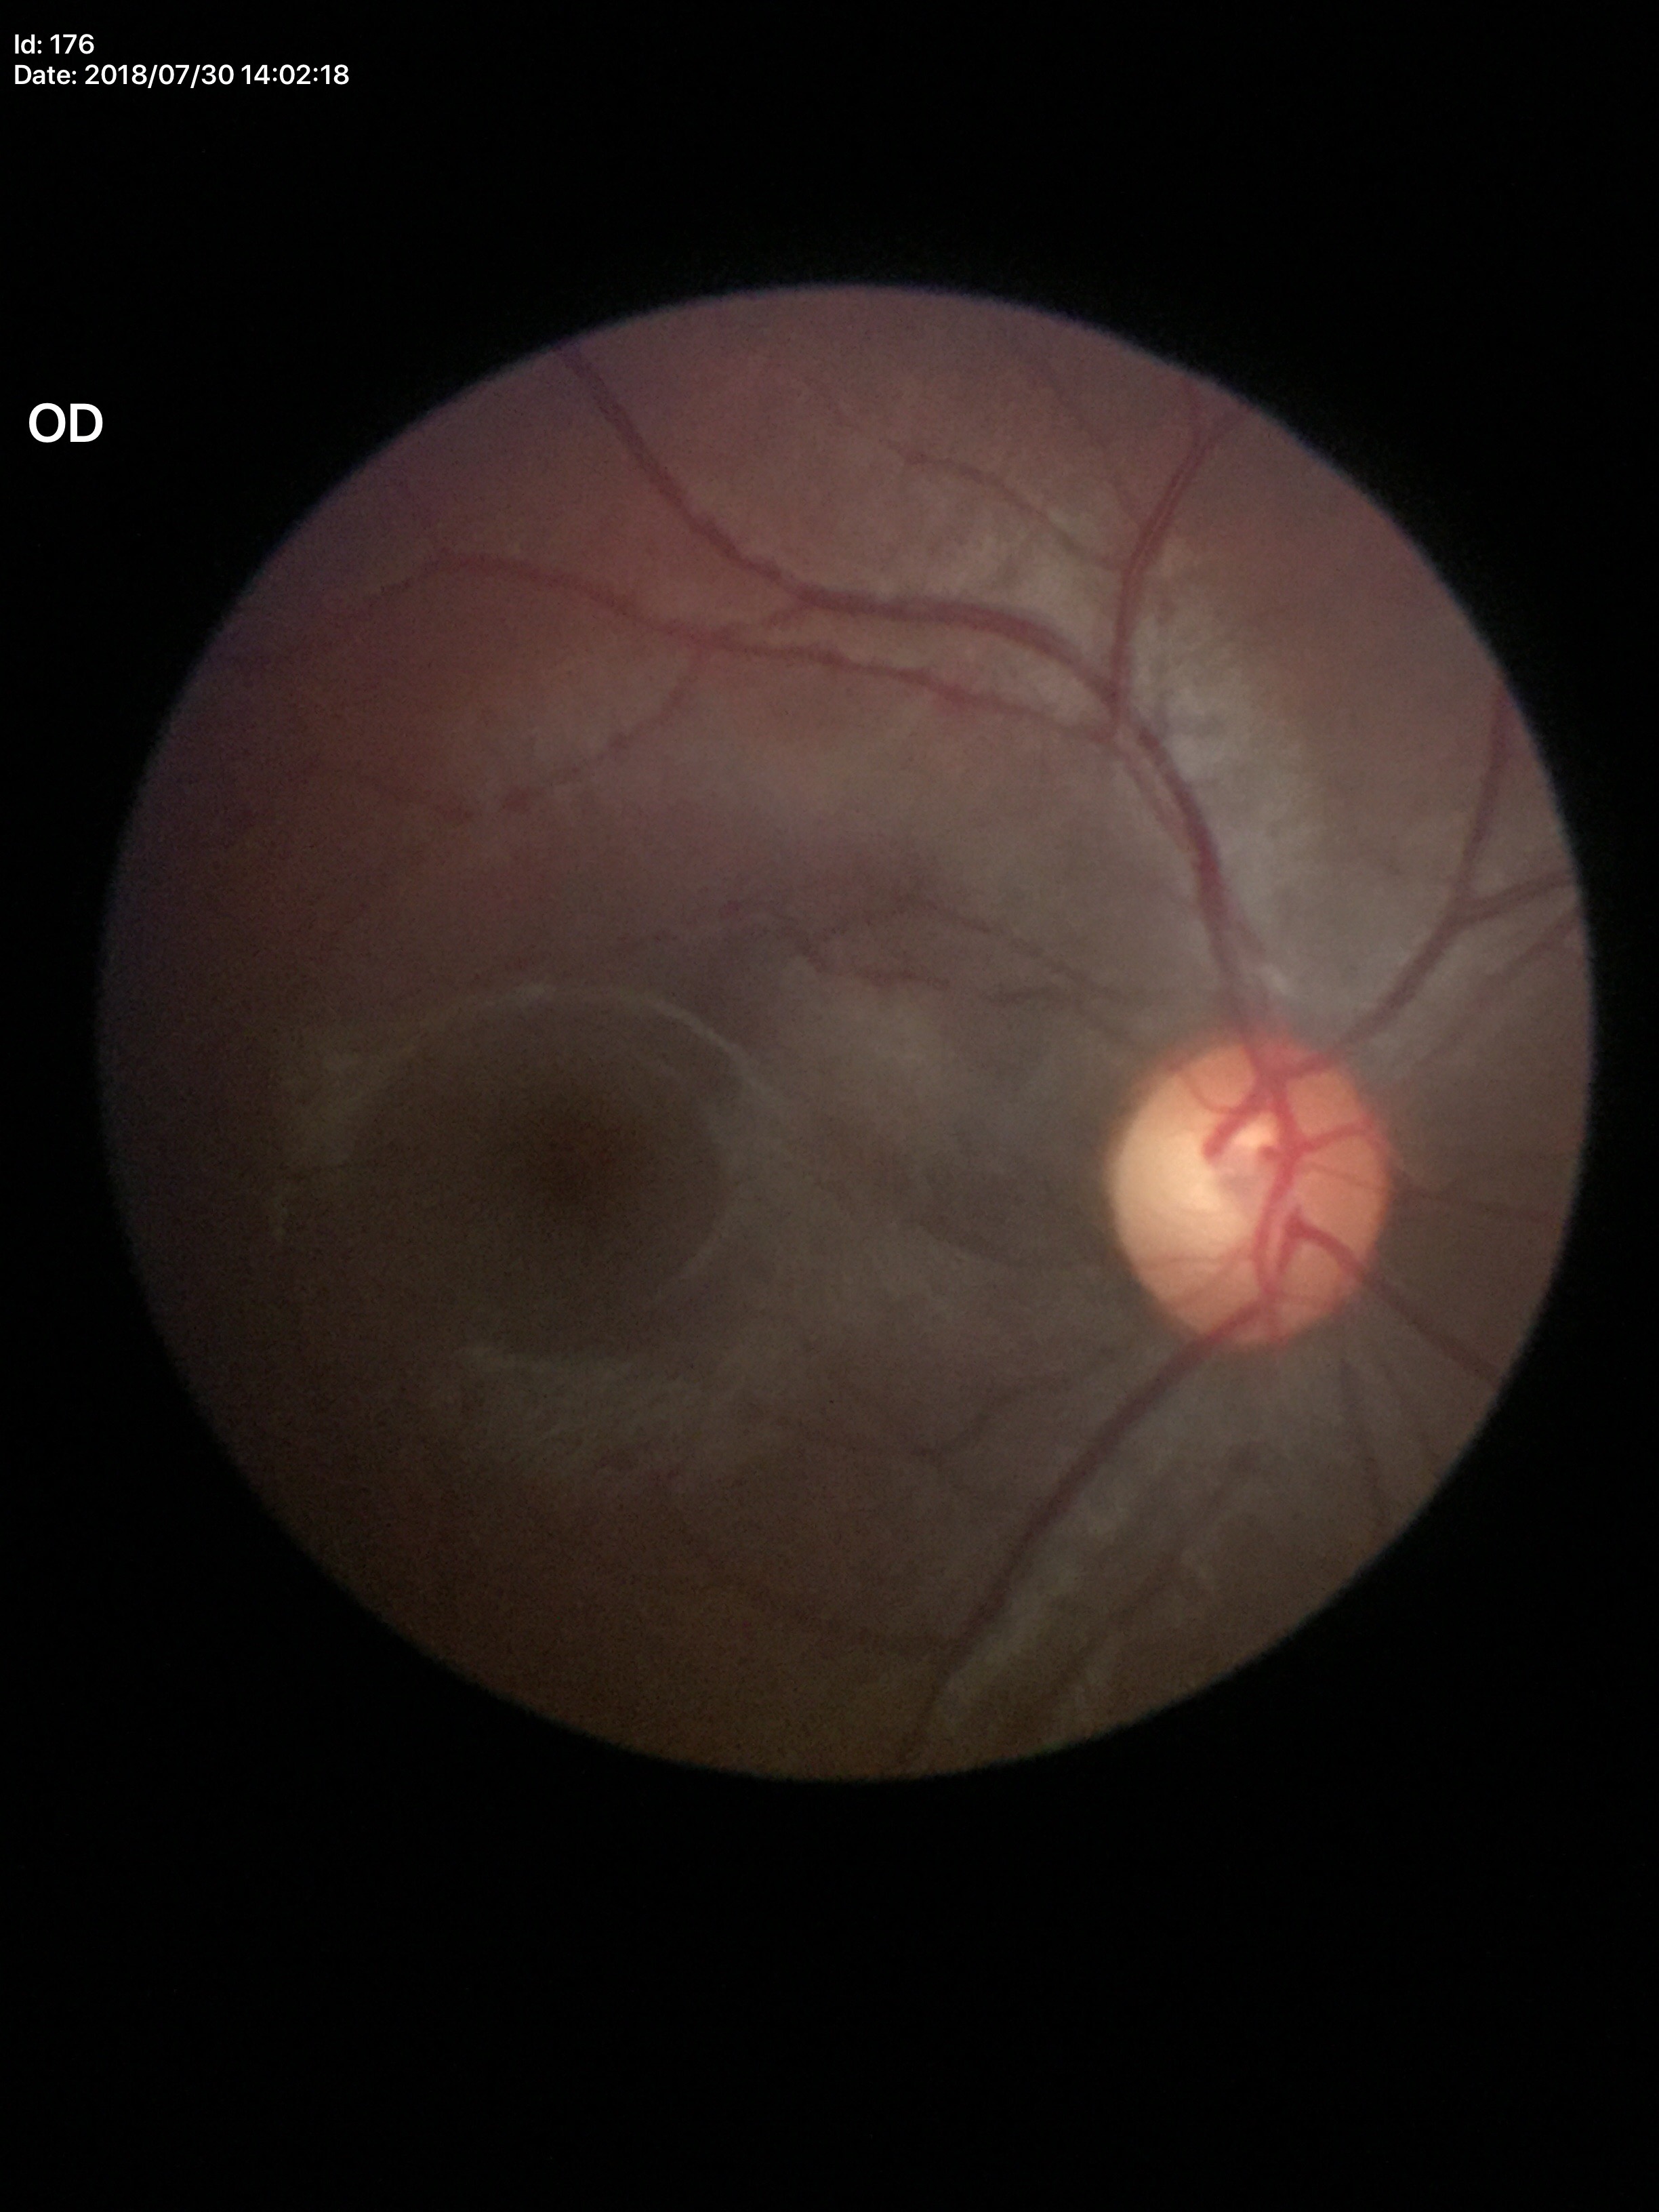

Annotations:
- vertical cup-to-disc ratio — 0.55
- Glaucoma assessment — no suspicious findings